Infant wide-field fundus photograph: 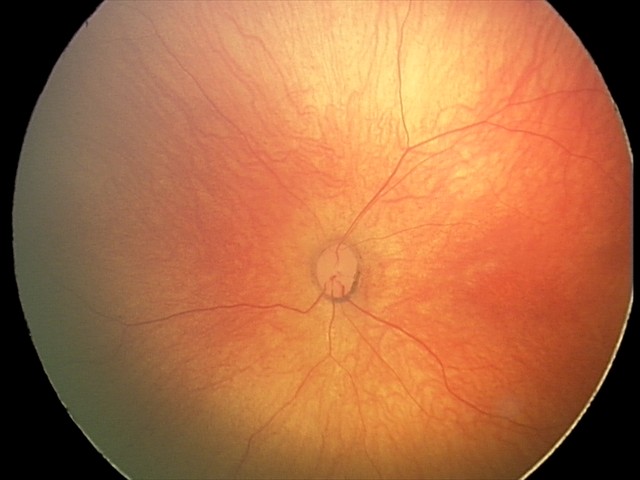

Finding: physiological appearance.